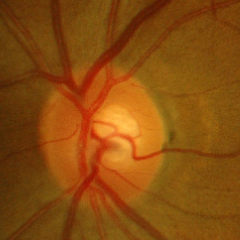

This fundus photograph shows early-stage glaucoma.